Mydriatic. Color fundus photograph centered on the optic disc:
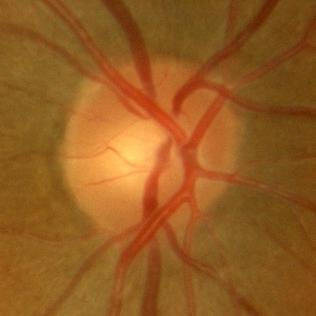 Glaucoma diagnosis: no glaucomatous damage.